50° field of view, image size 1924x1556:
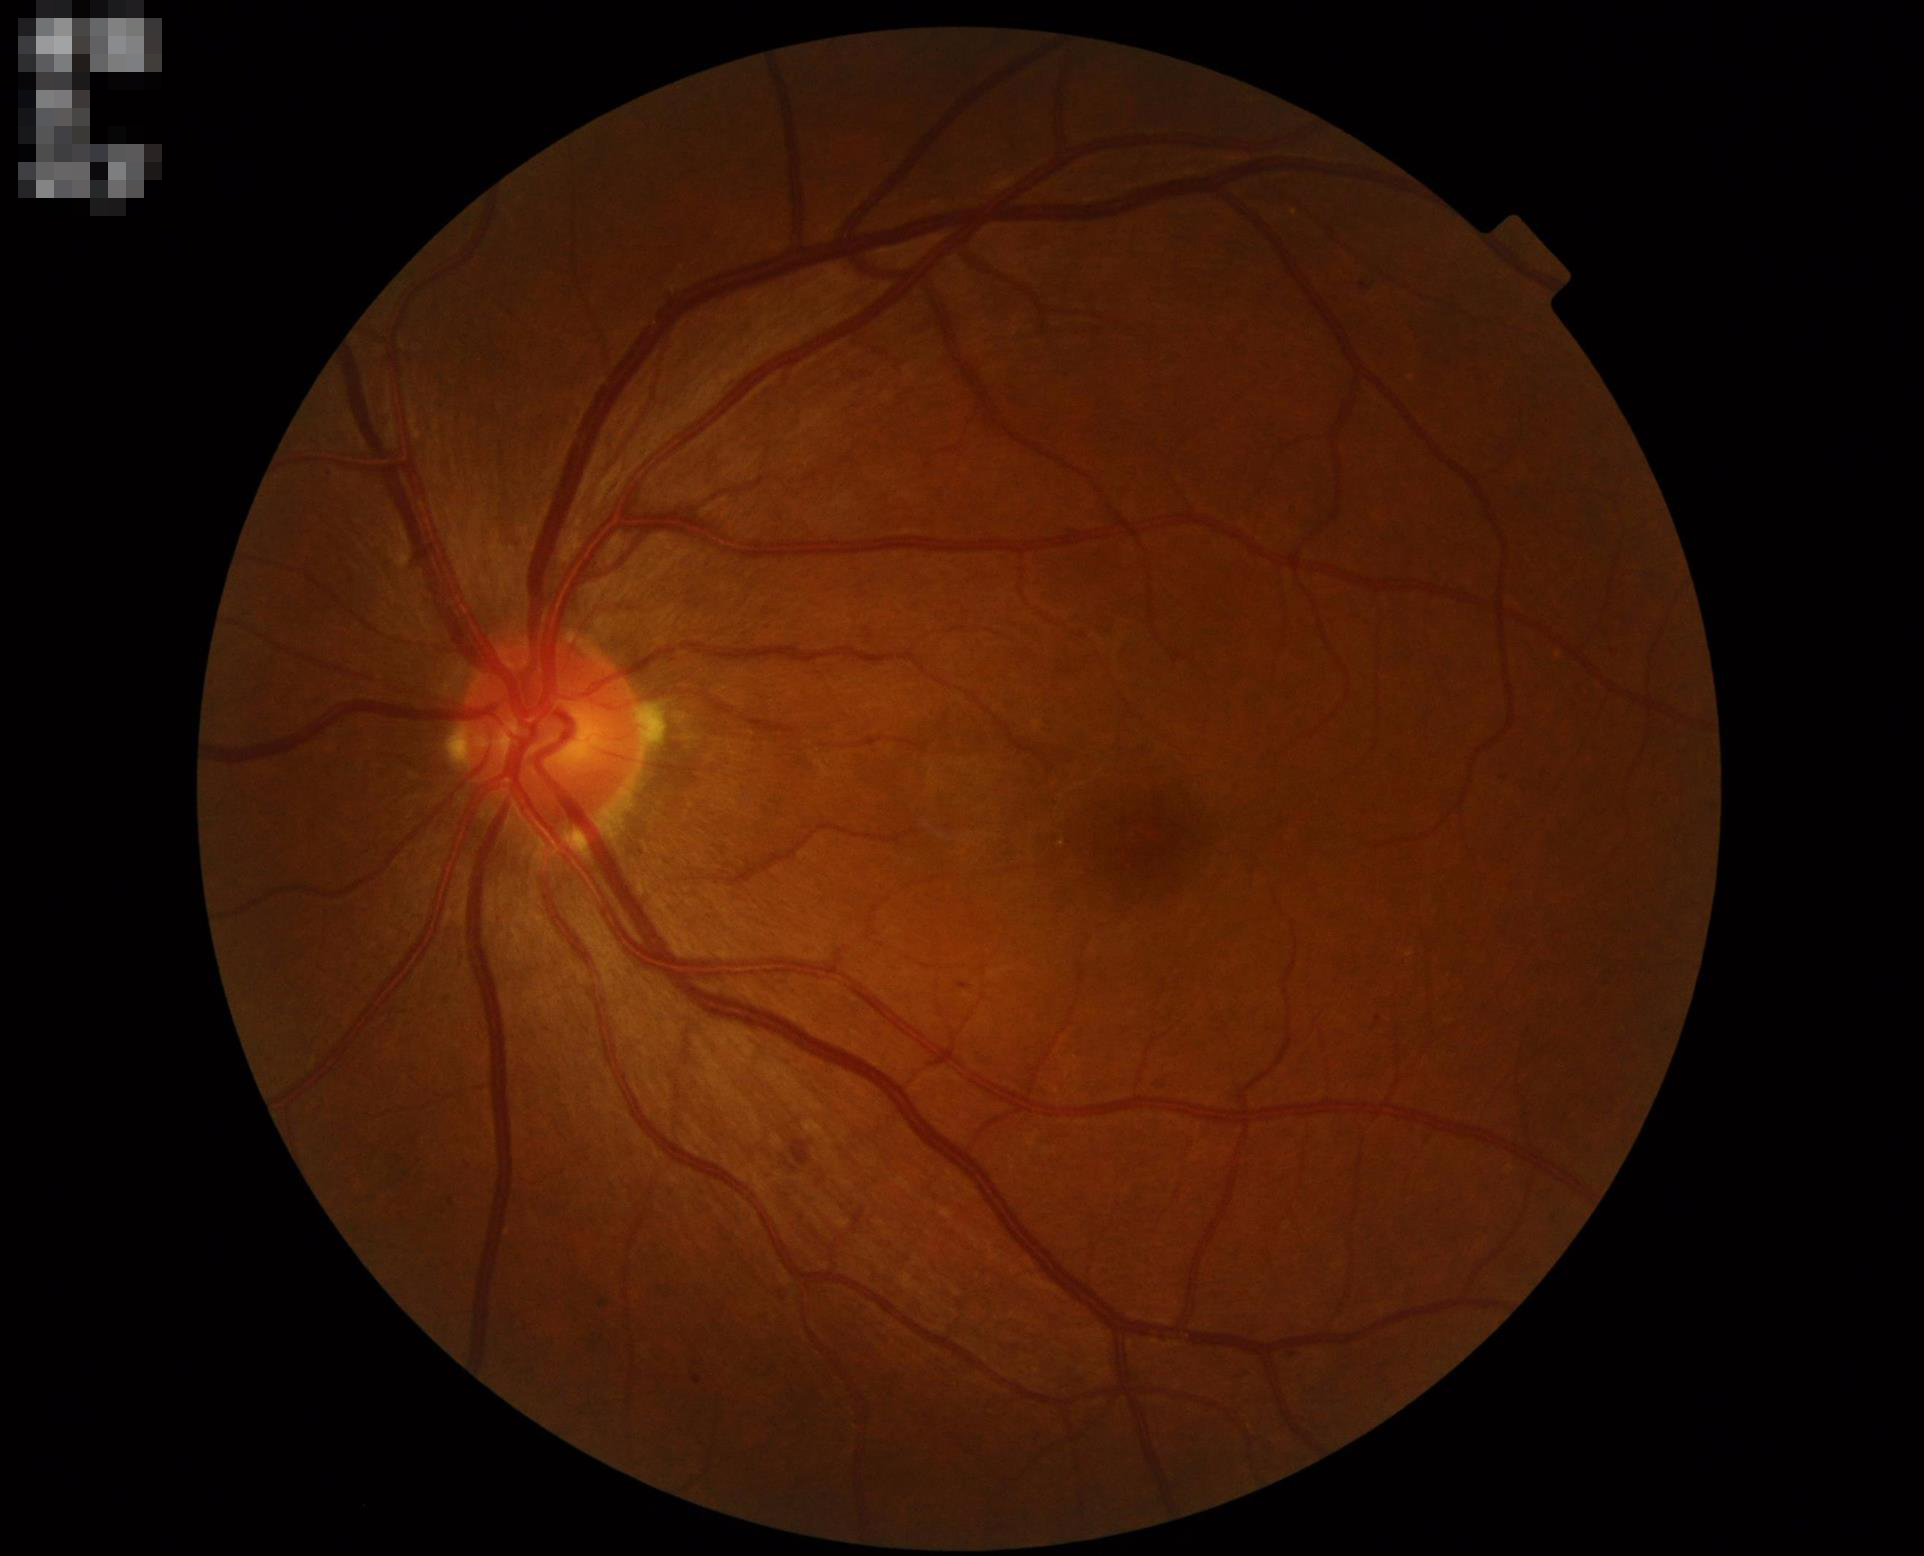 illumination: no over- or under-exposure
clarity: optic disc, vessels, and background in focus
contrast: good dynamic range
overall_quality: good, gradable